Wide-field fundus photograph of an infant · 1240x1240px · Phoenix ICON, 100° FOV: 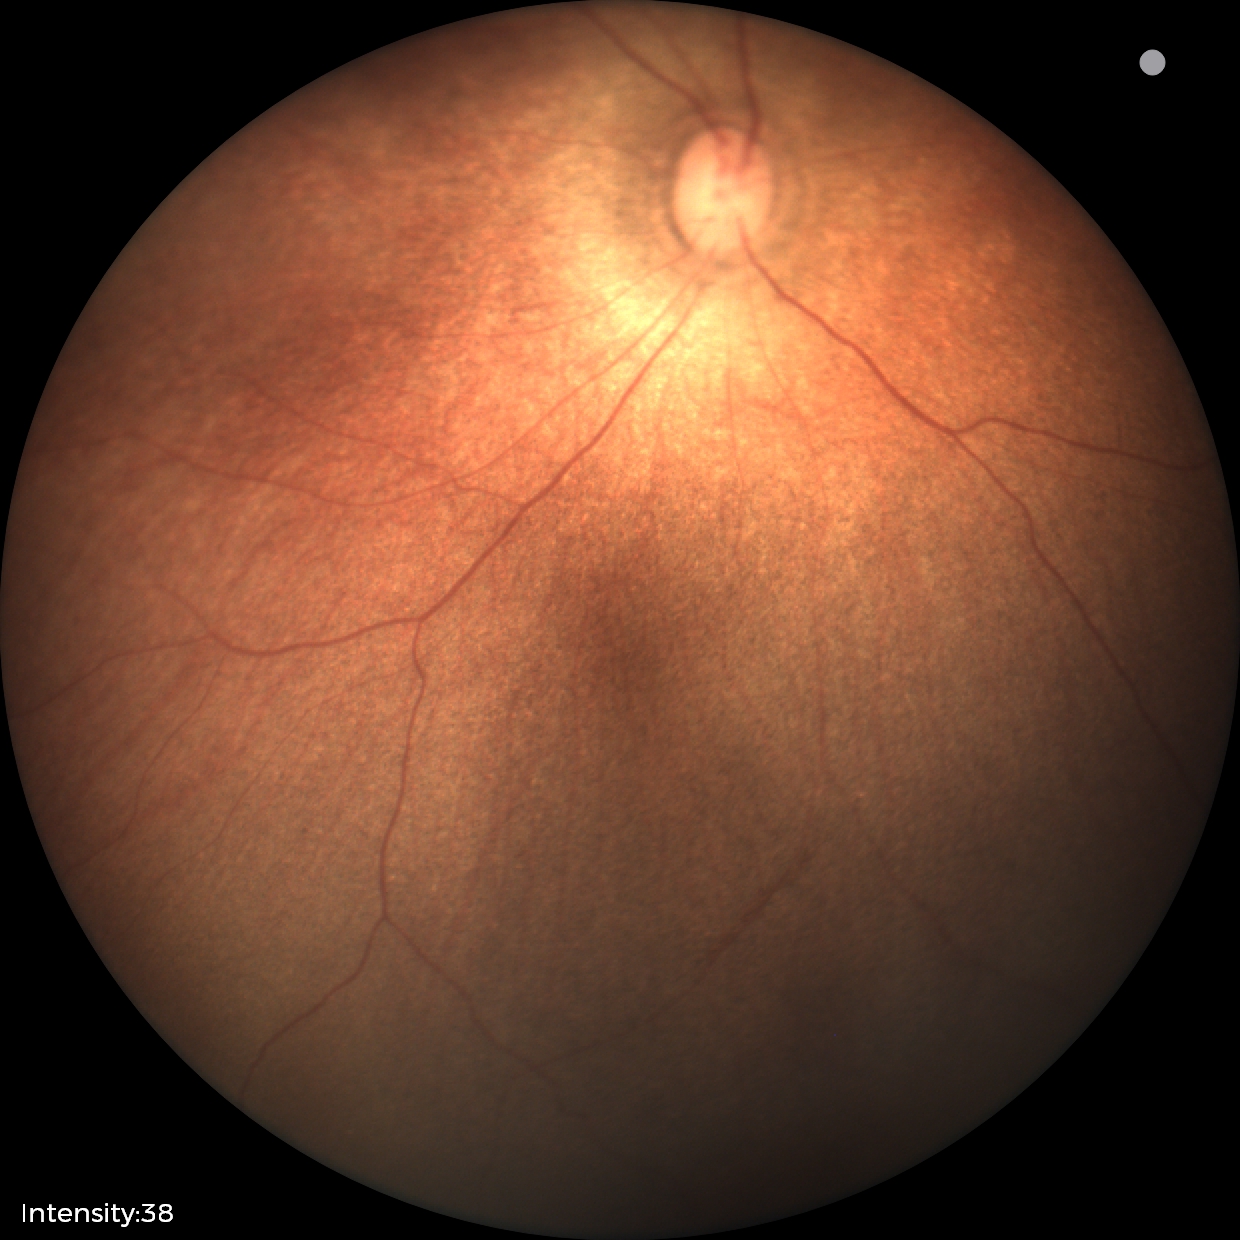
Physiological retinal appearance for postconceptual age.